Image size 1932x1916: 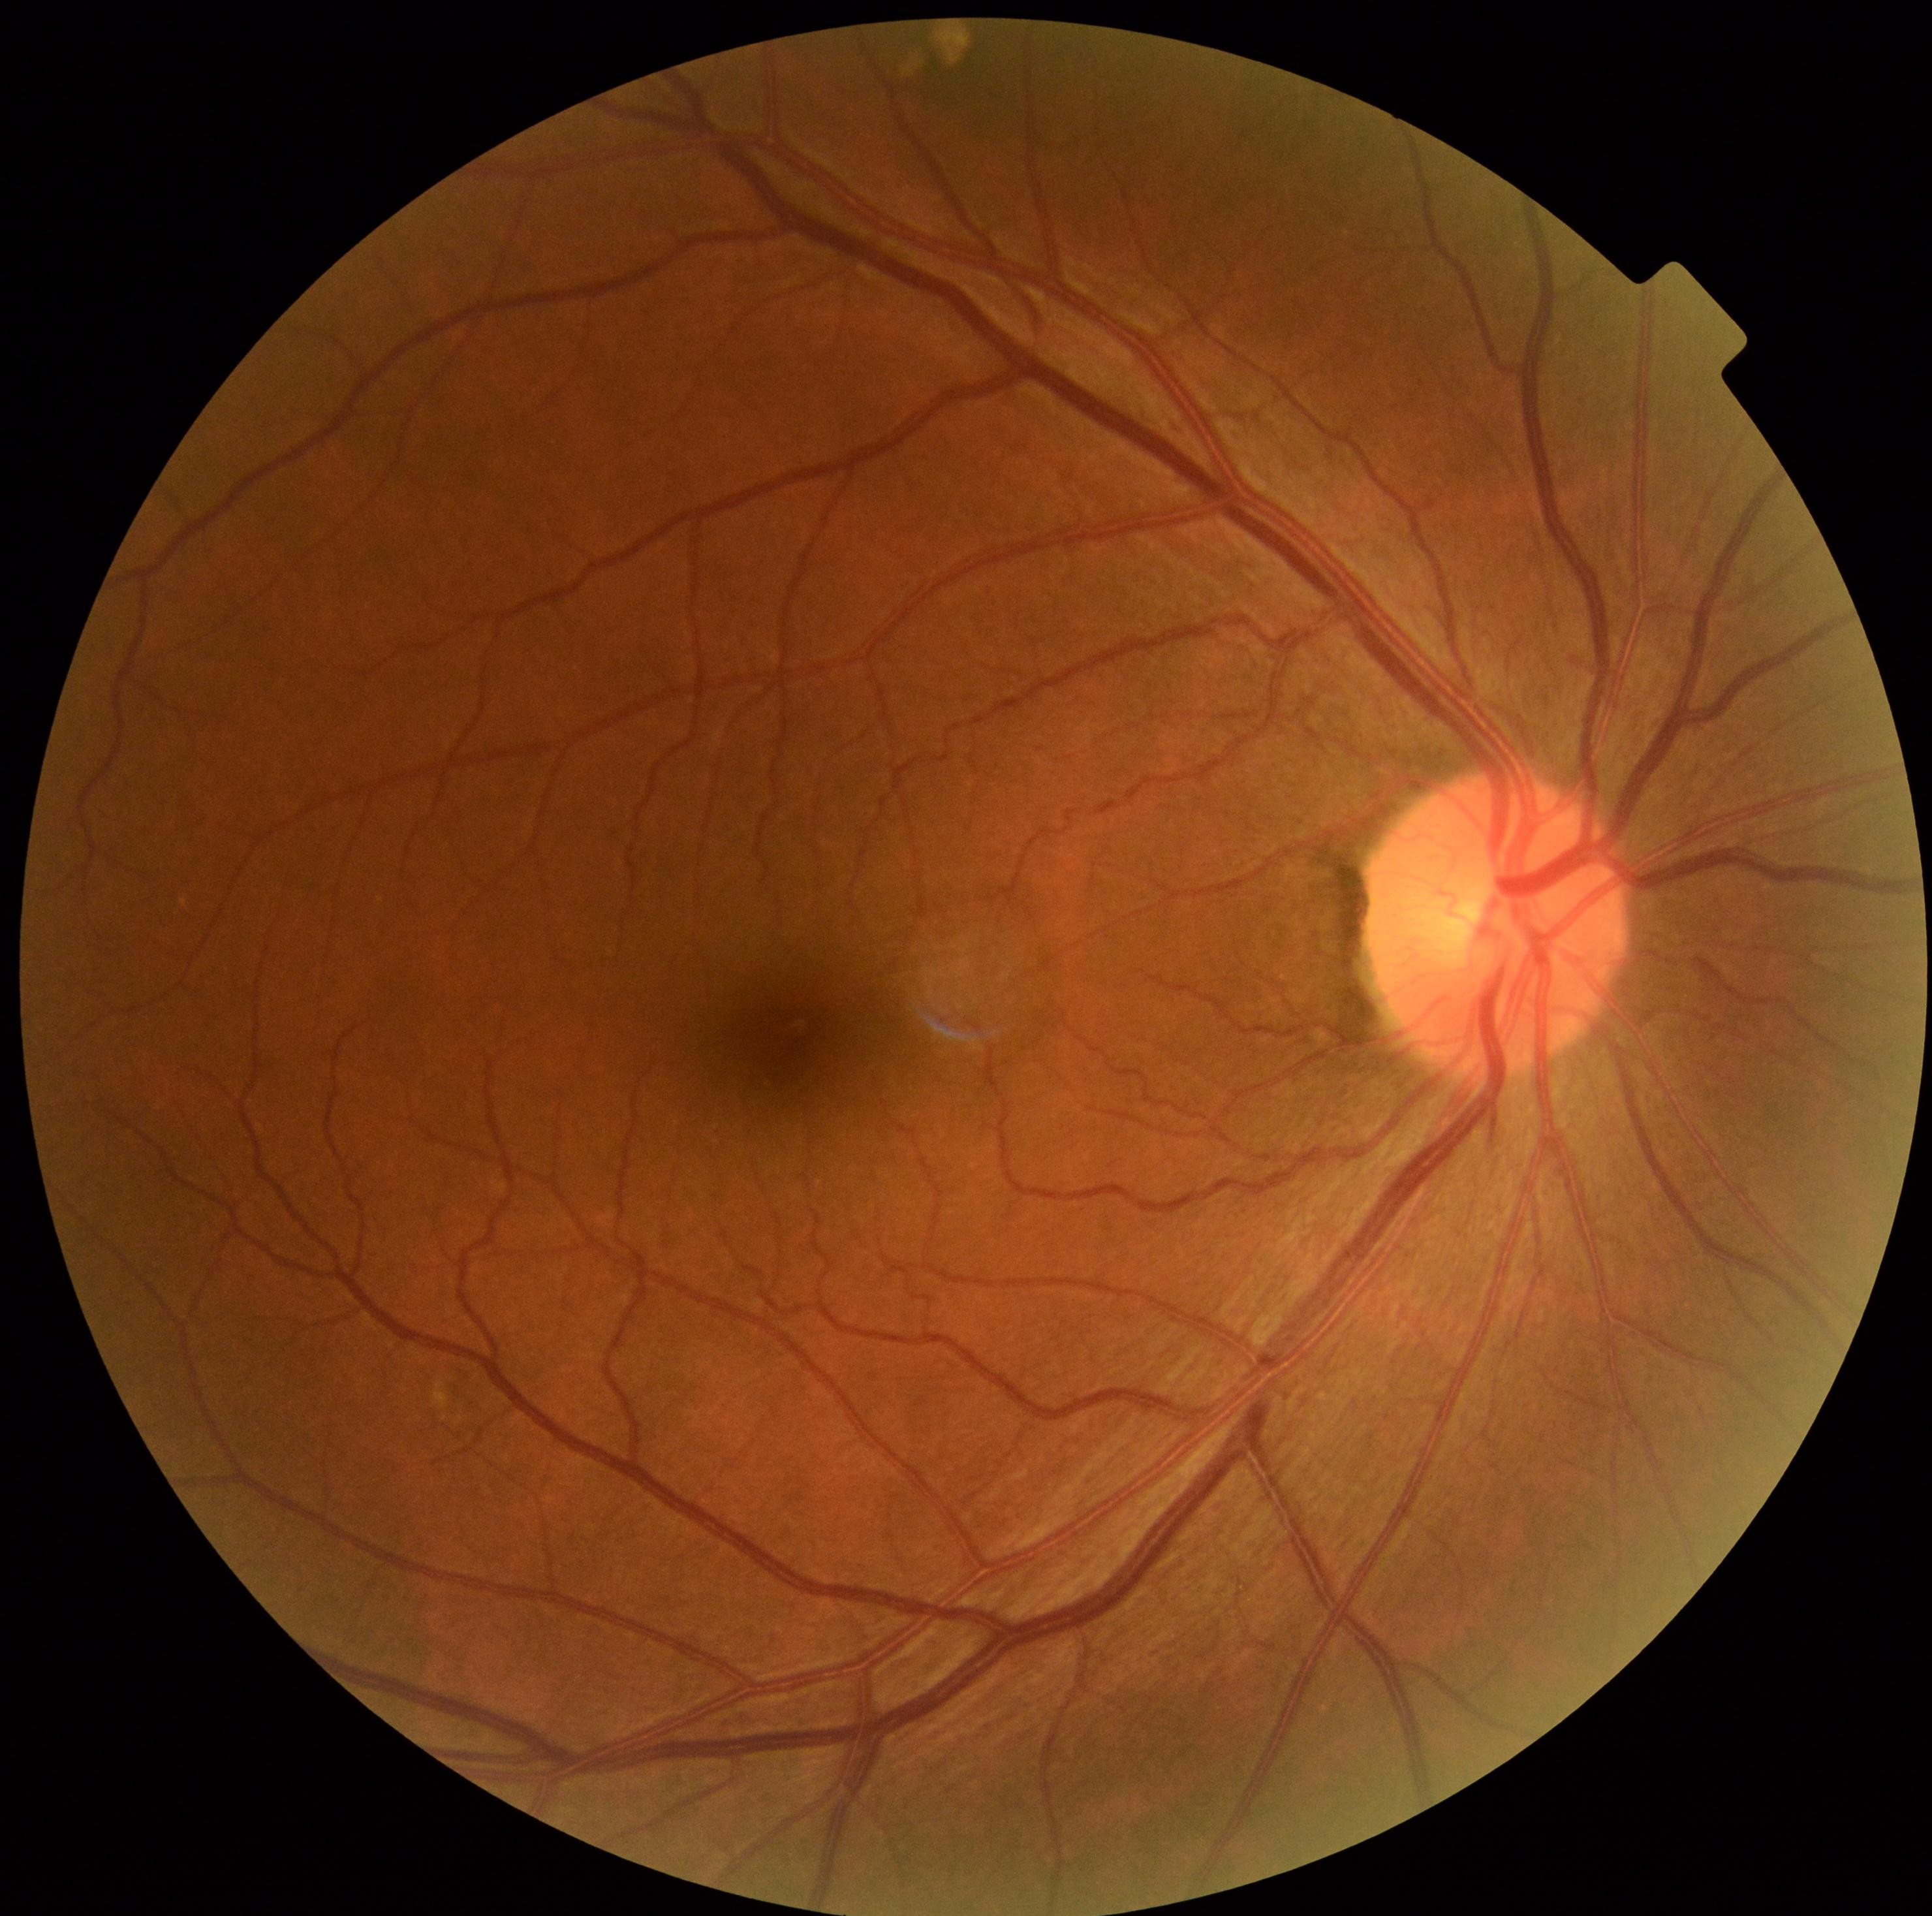

DR severity is 0.
No diabetic retinal disease findings.